Davis DR grading · 45 degree fundus photograph · nonmydriatic · 848 by 848 pixels · fundus photo · camera: NIDEK AFC-230
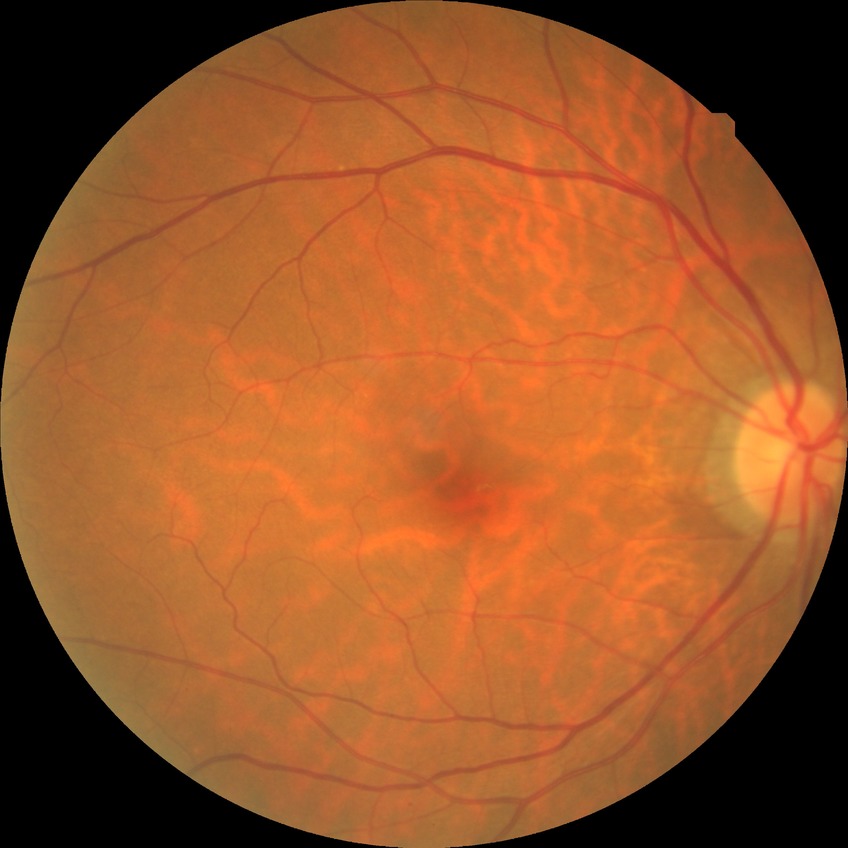
davis_grade: no diabetic retinopathy (NDR)